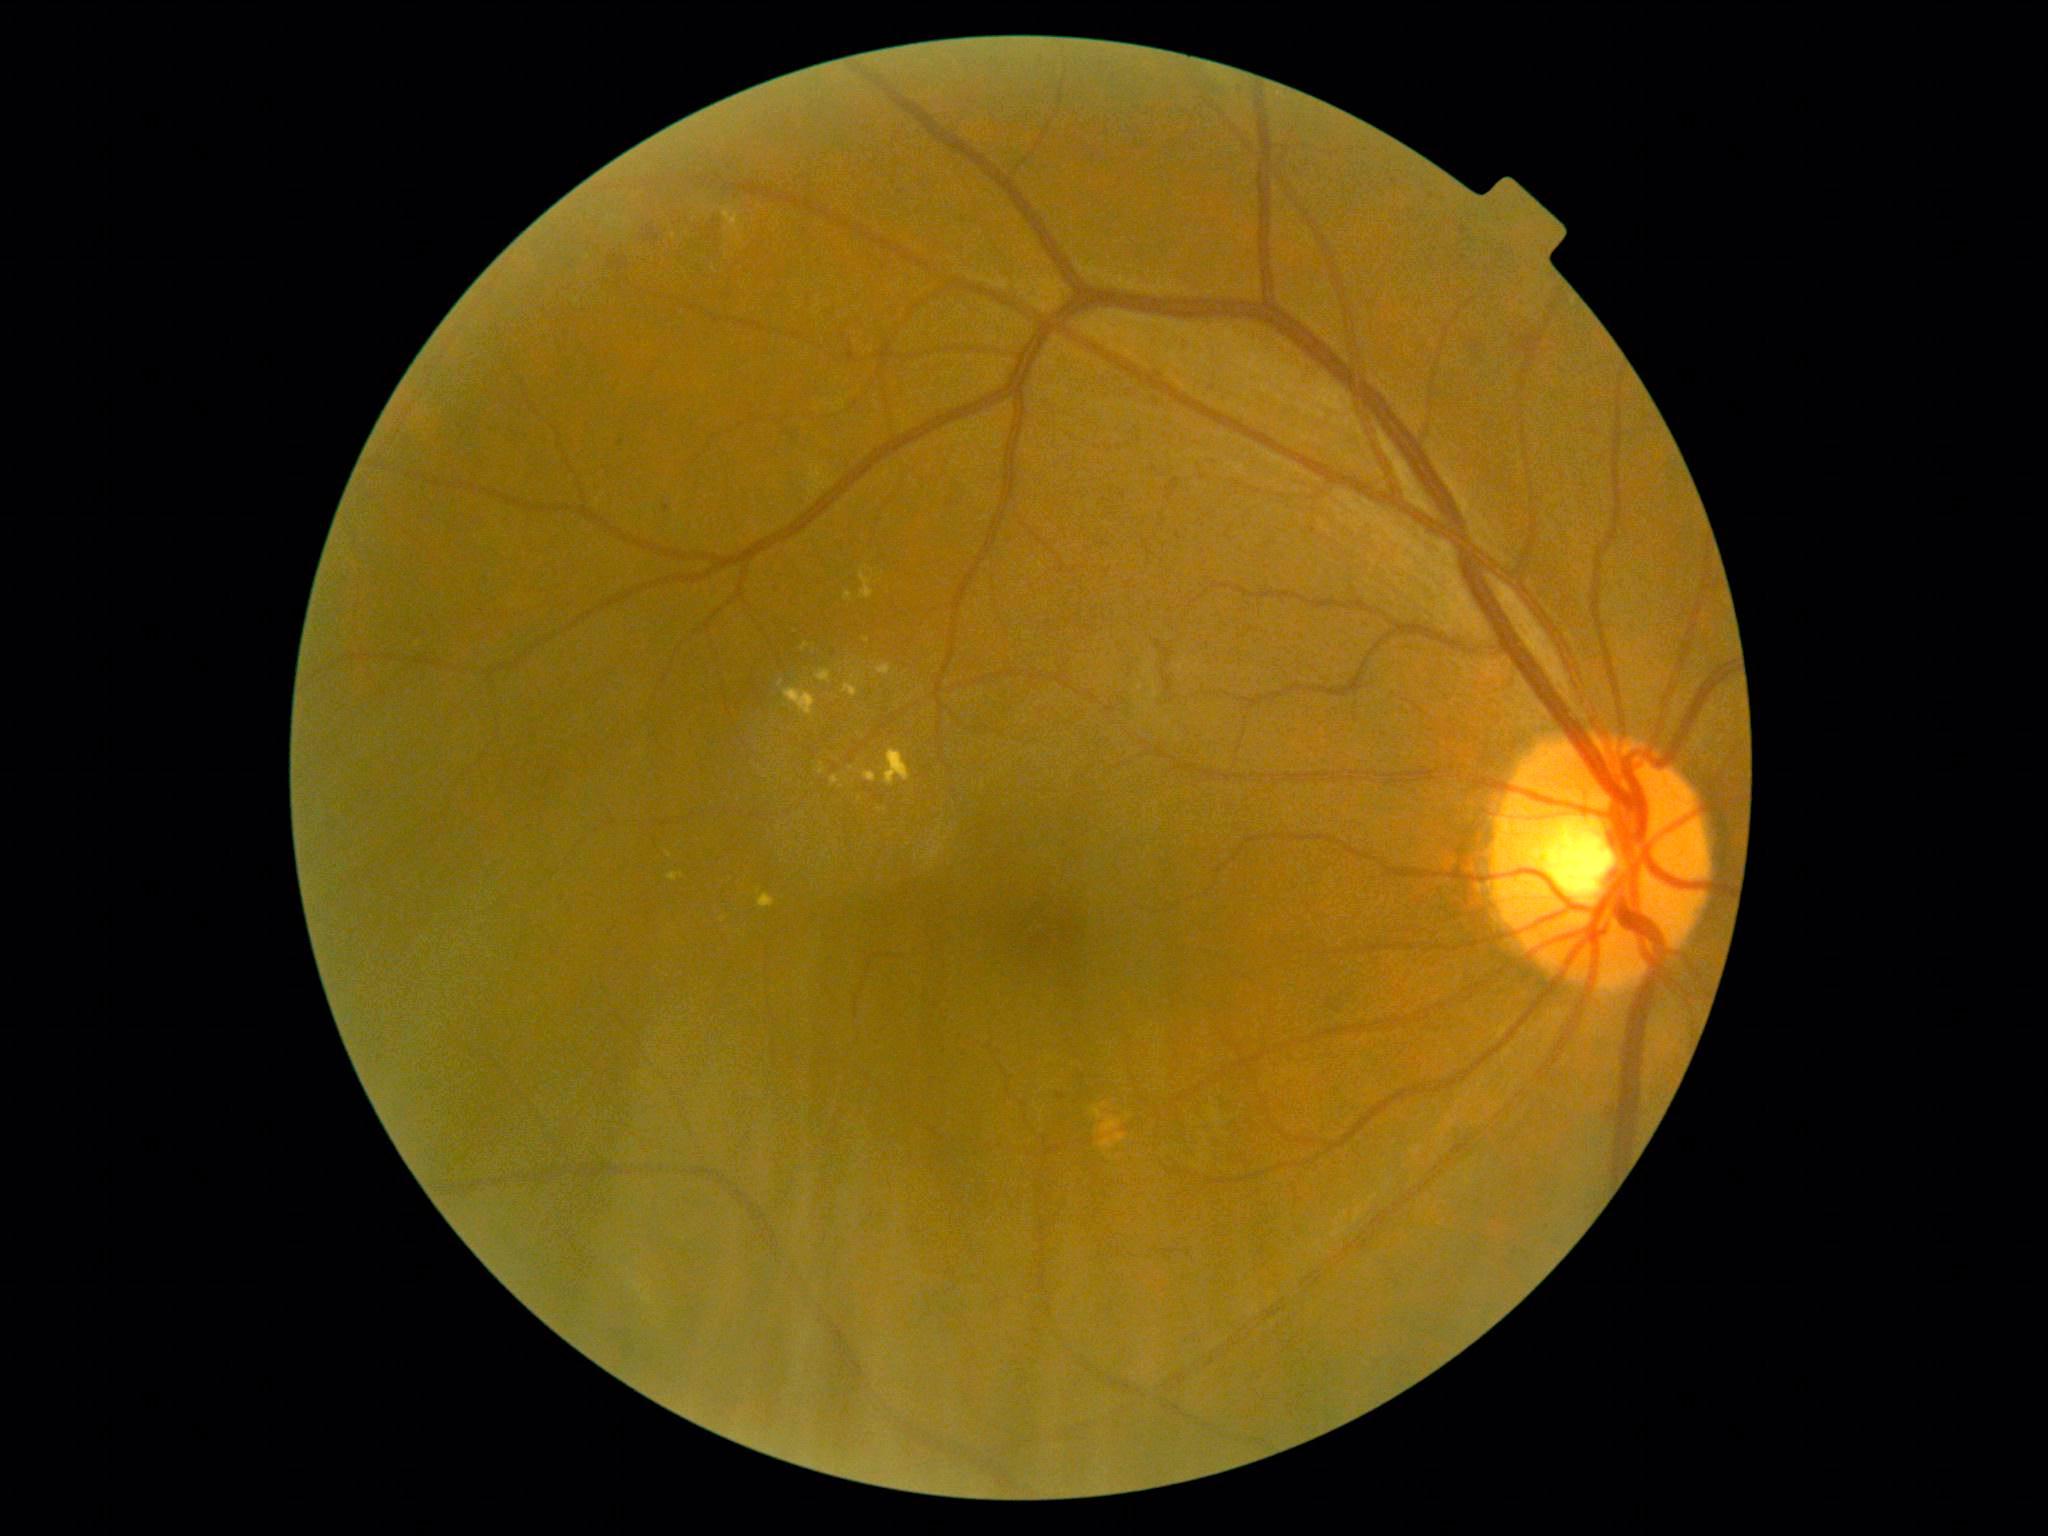
Disease class: non-proliferative diabetic retinopathy. Retinopathy is moderate NPDR (grade 2) — more than just microaneurysms but less than severe NPDR.